45-degree field of view. 848 by 848 pixels. Fundus photo. Without pupil dilation
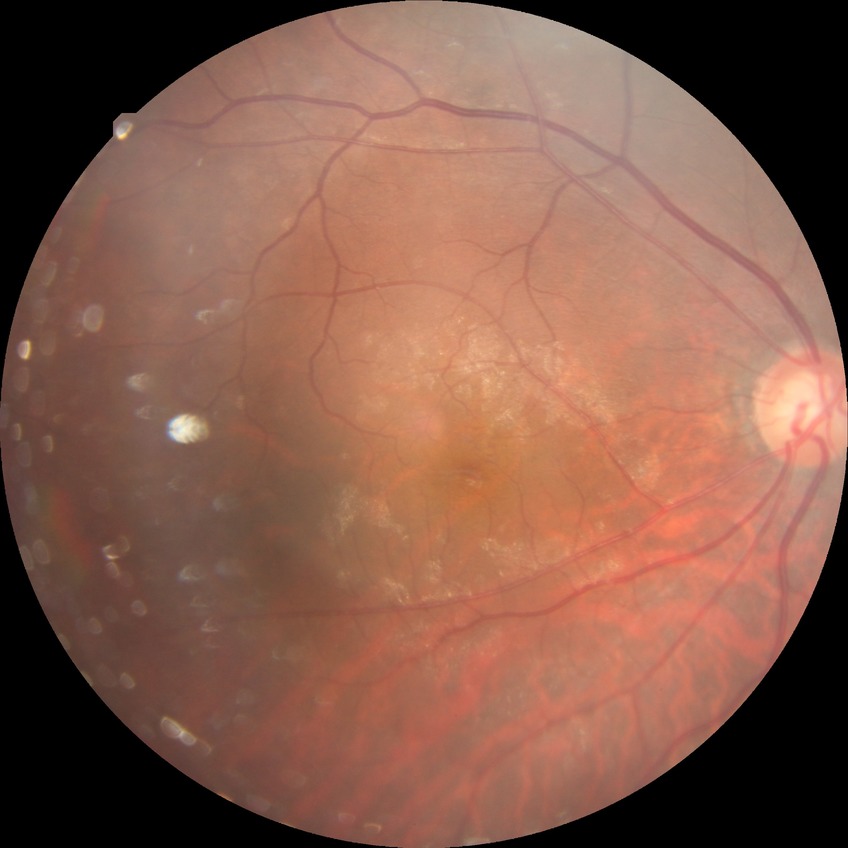 modified Davis grading = simple diabetic retinopathy.